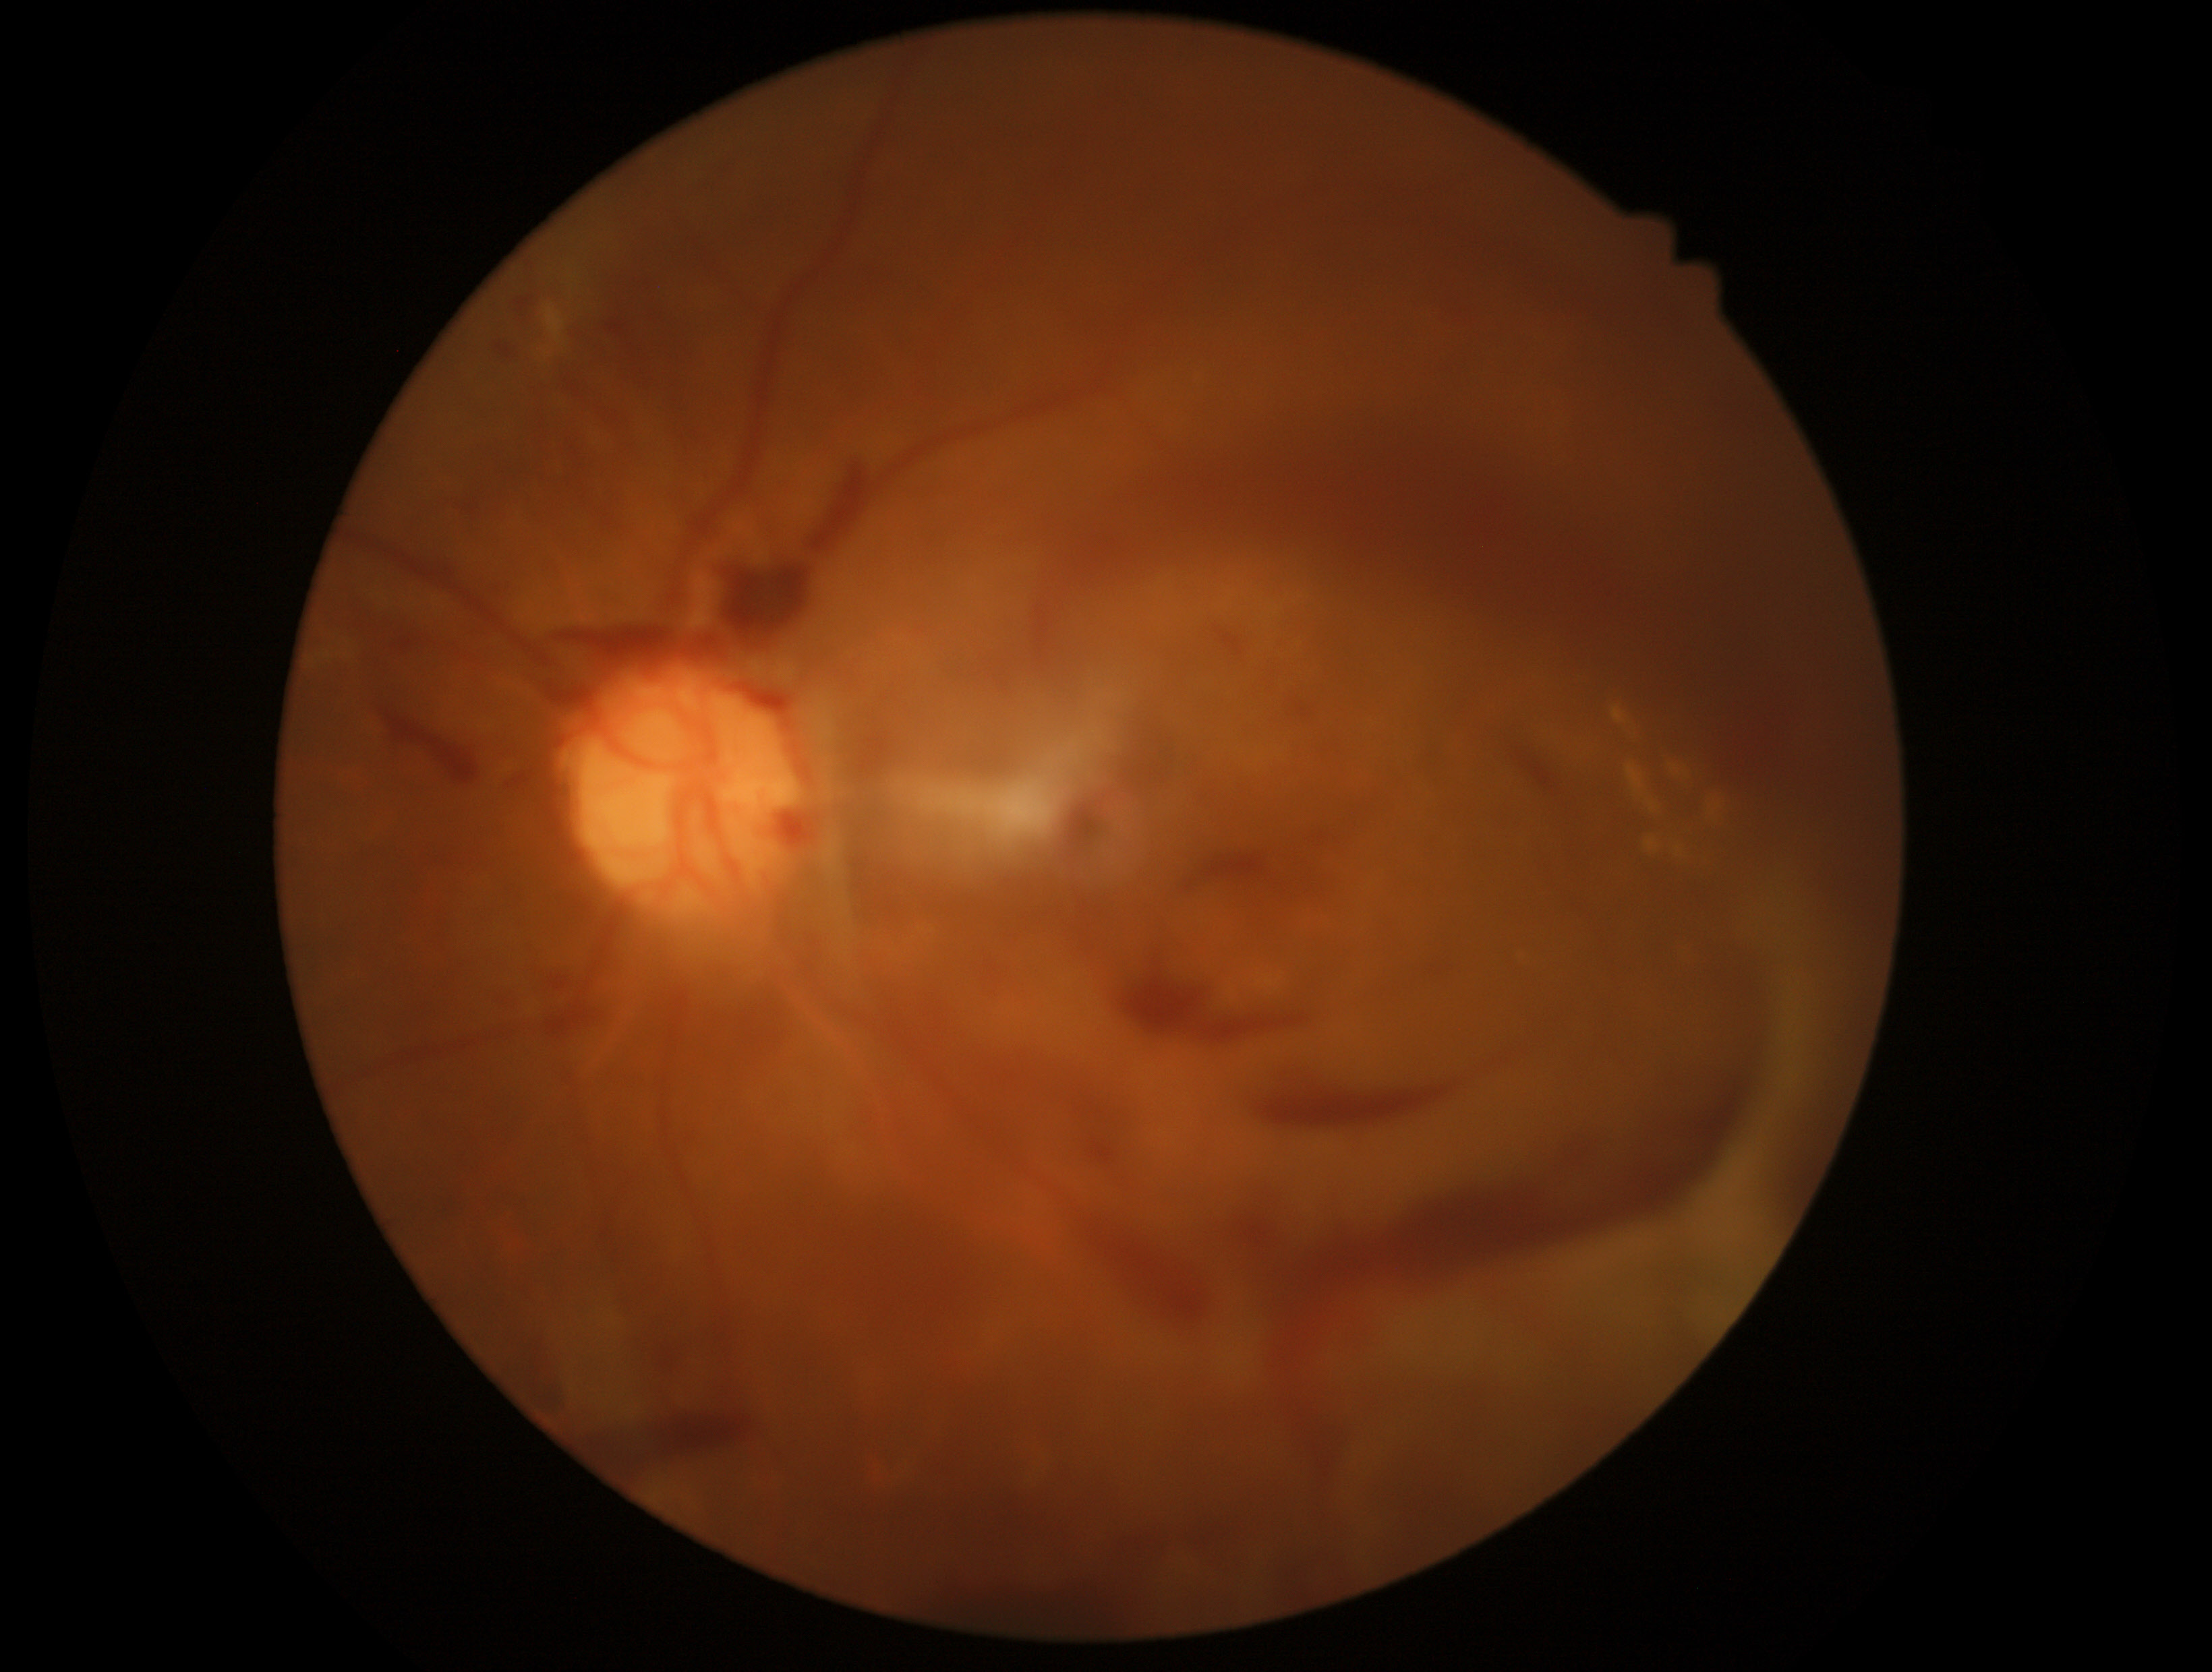

Diabetic retinopathy: 4/4 — neovascularization and/or vitreous/pre-retinal hemorrhage.
DR class: proliferative diabetic retinopathy.